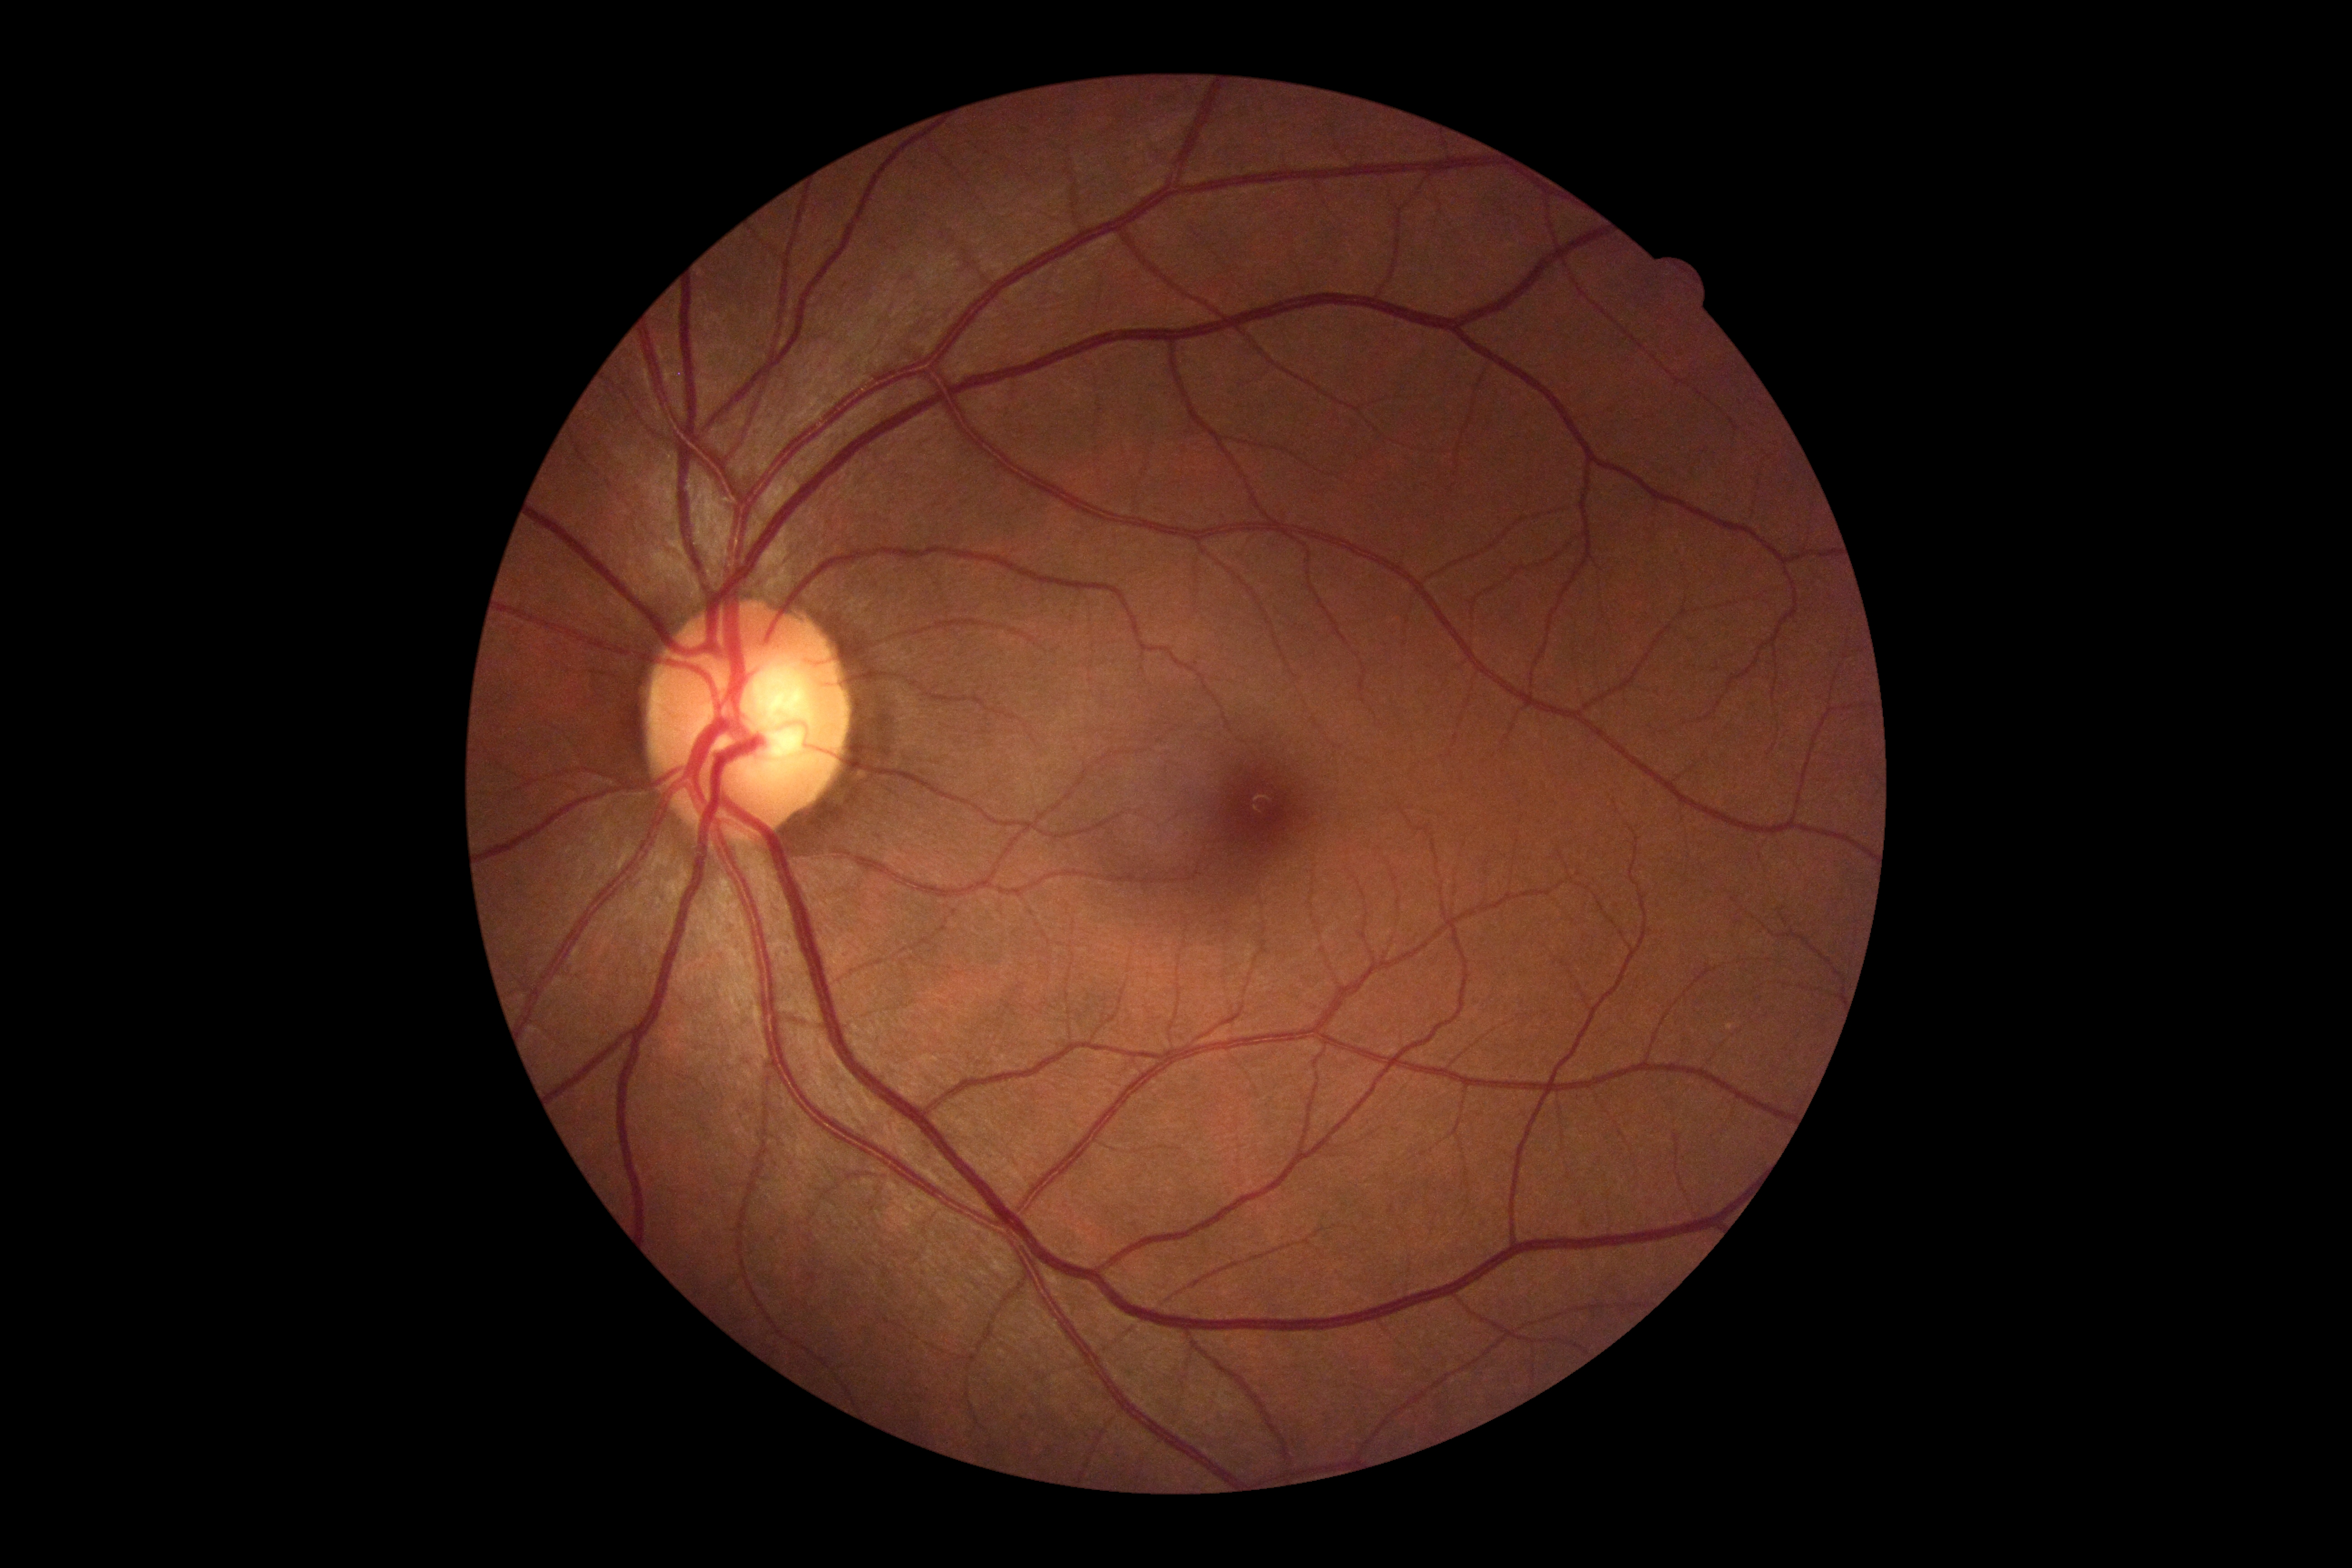

Retinopathy grade: 0 — no visible signs of diabetic retinopathy. No signs of diabetic retinopathy.